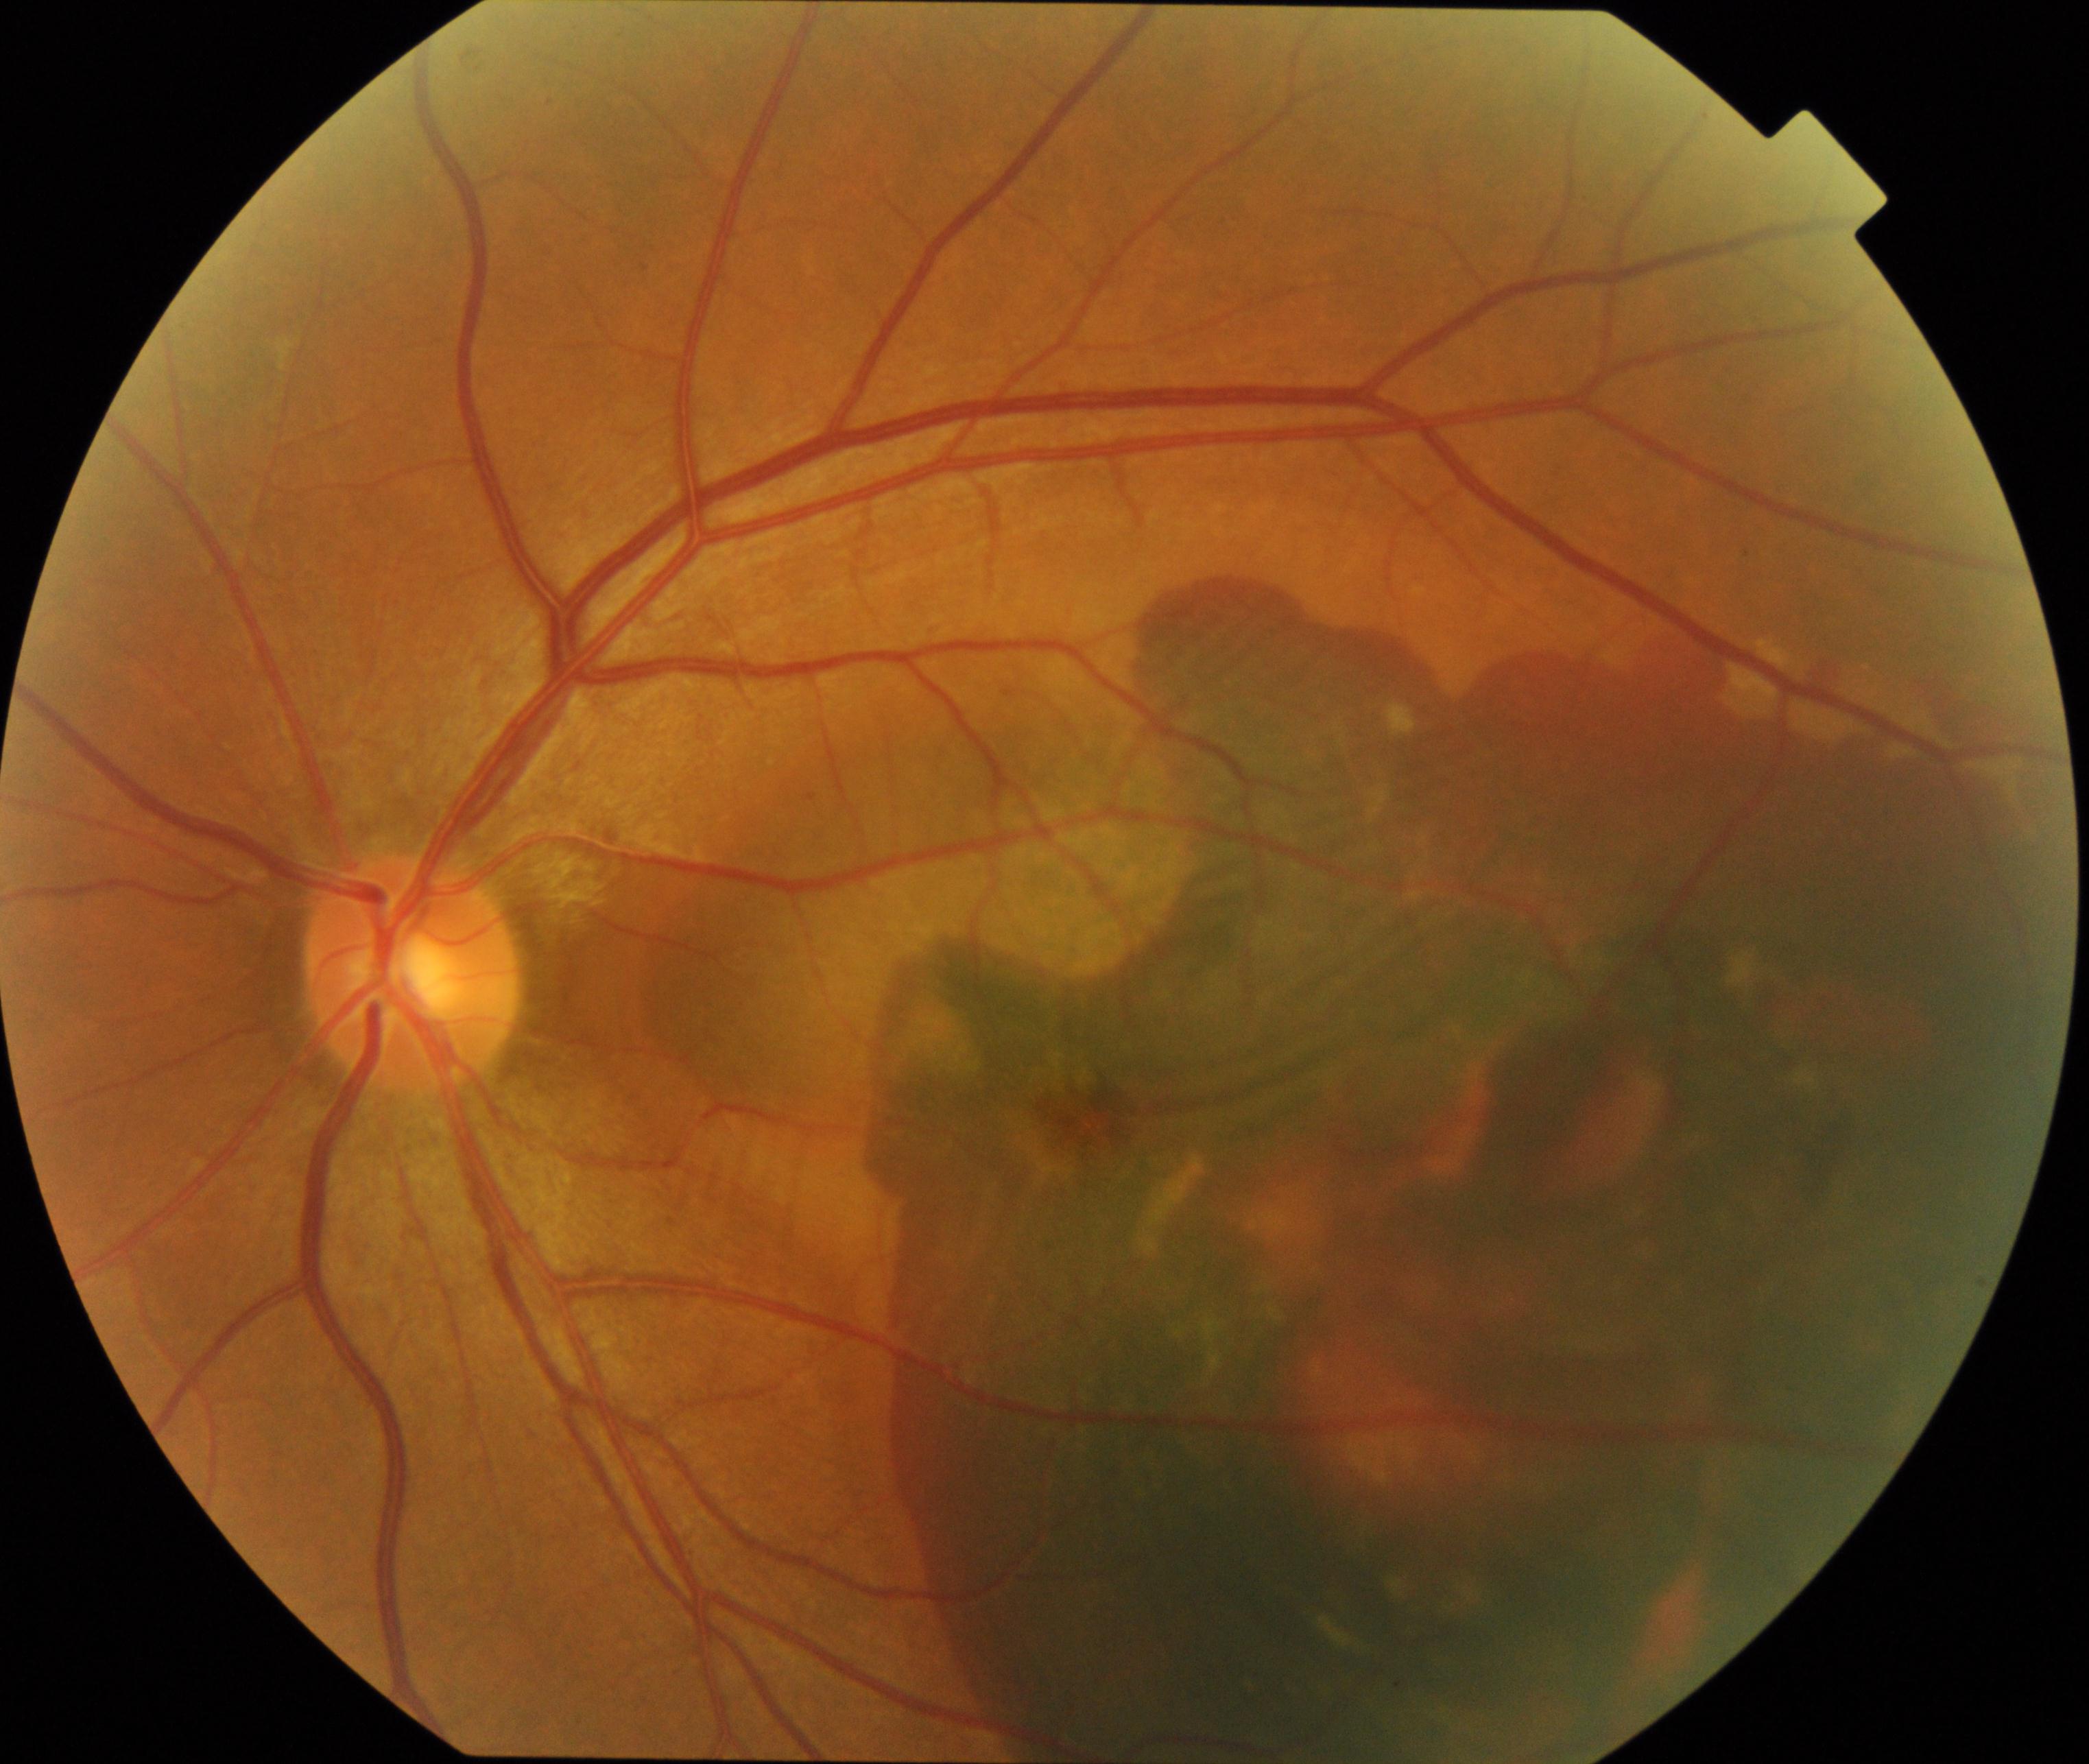

Demonstrates maculopathy.